Acquired with a Topcon TRC-50DX
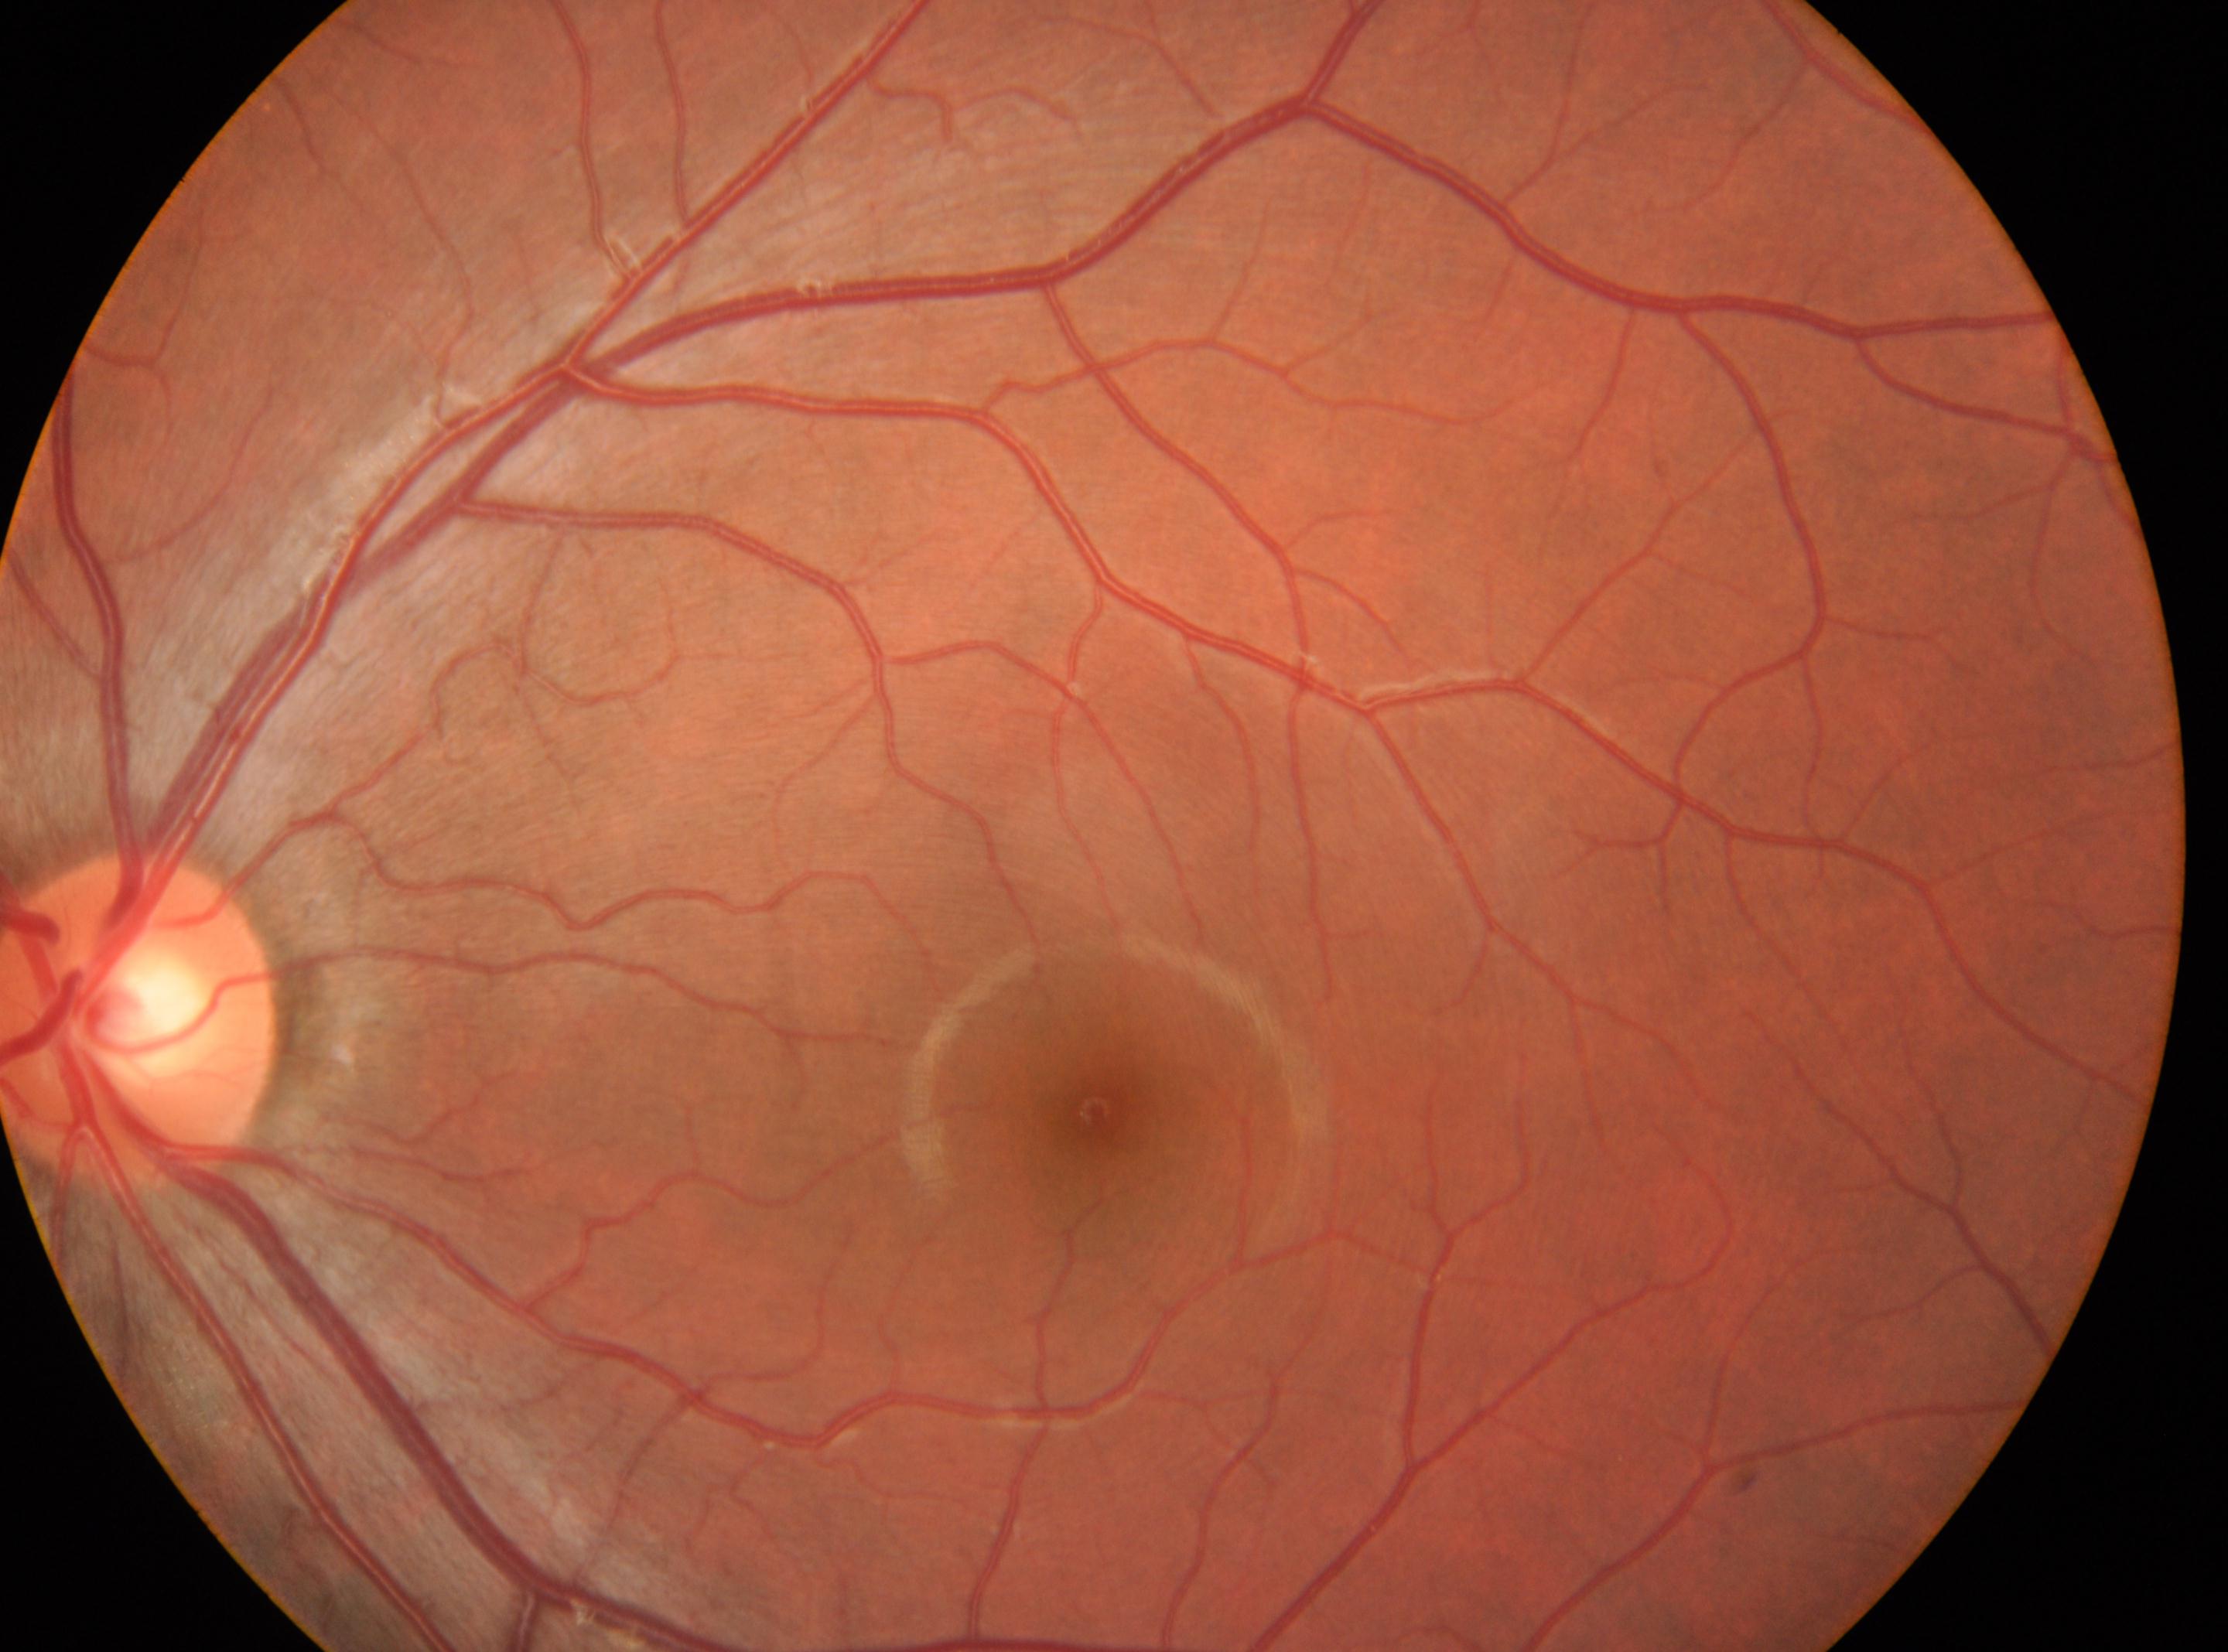

dr_grade: no apparent retinopathy (0)
eye: oculus sinister
fovea: (1095,1111)
optic_disc: (141,1019)